Acquired on the Phoenix ICON; infant wide-field fundus photograph — 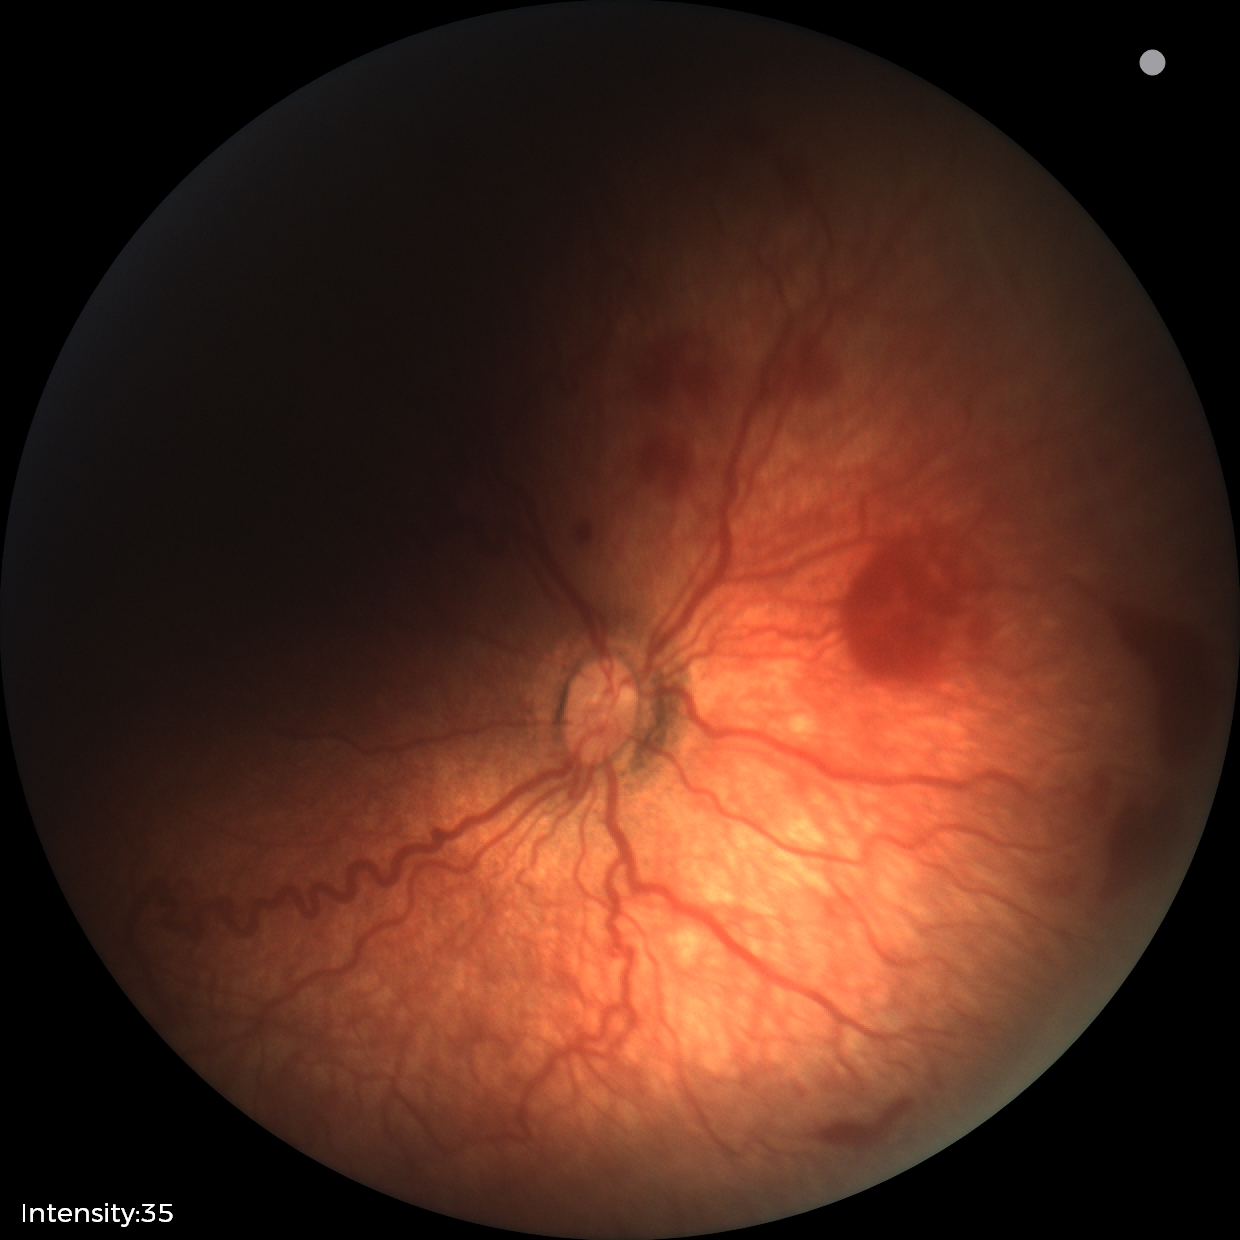
Assessment: ROP stage 2 | plus disease — abnormal dilation and tortuosity of the posterior pole retinal vessels.